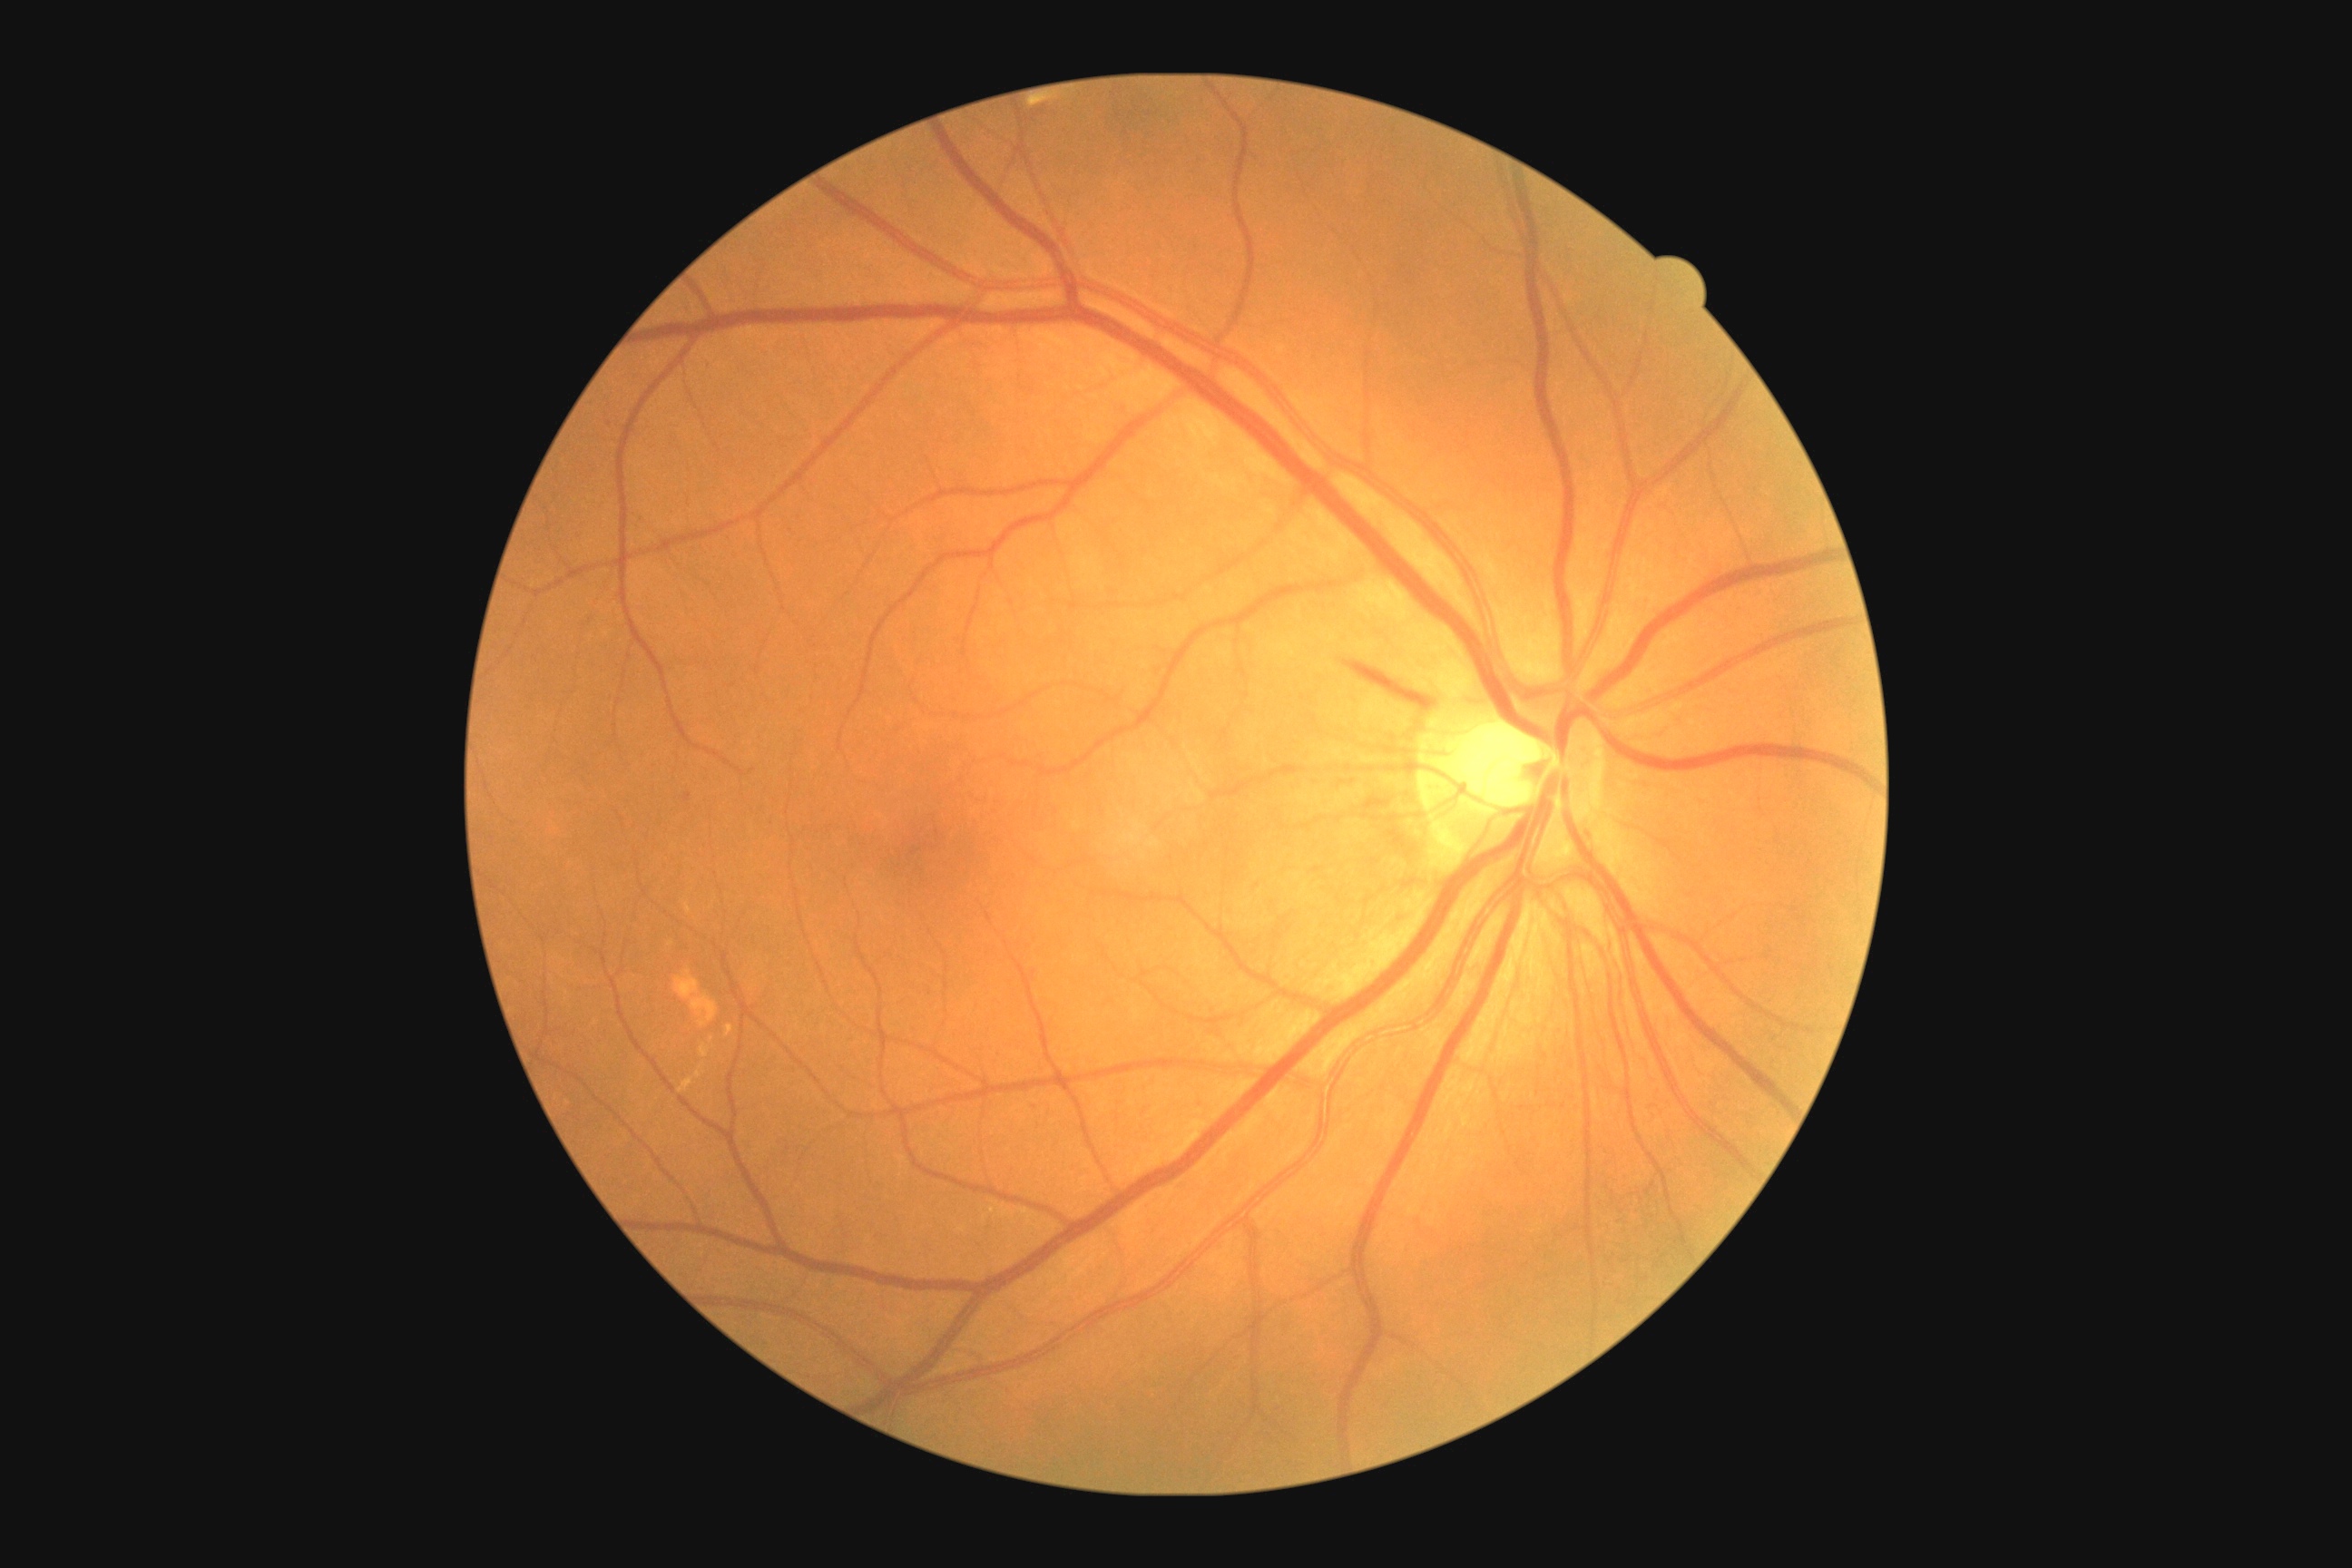
  dr_grade: moderate NPDR (grade 2)